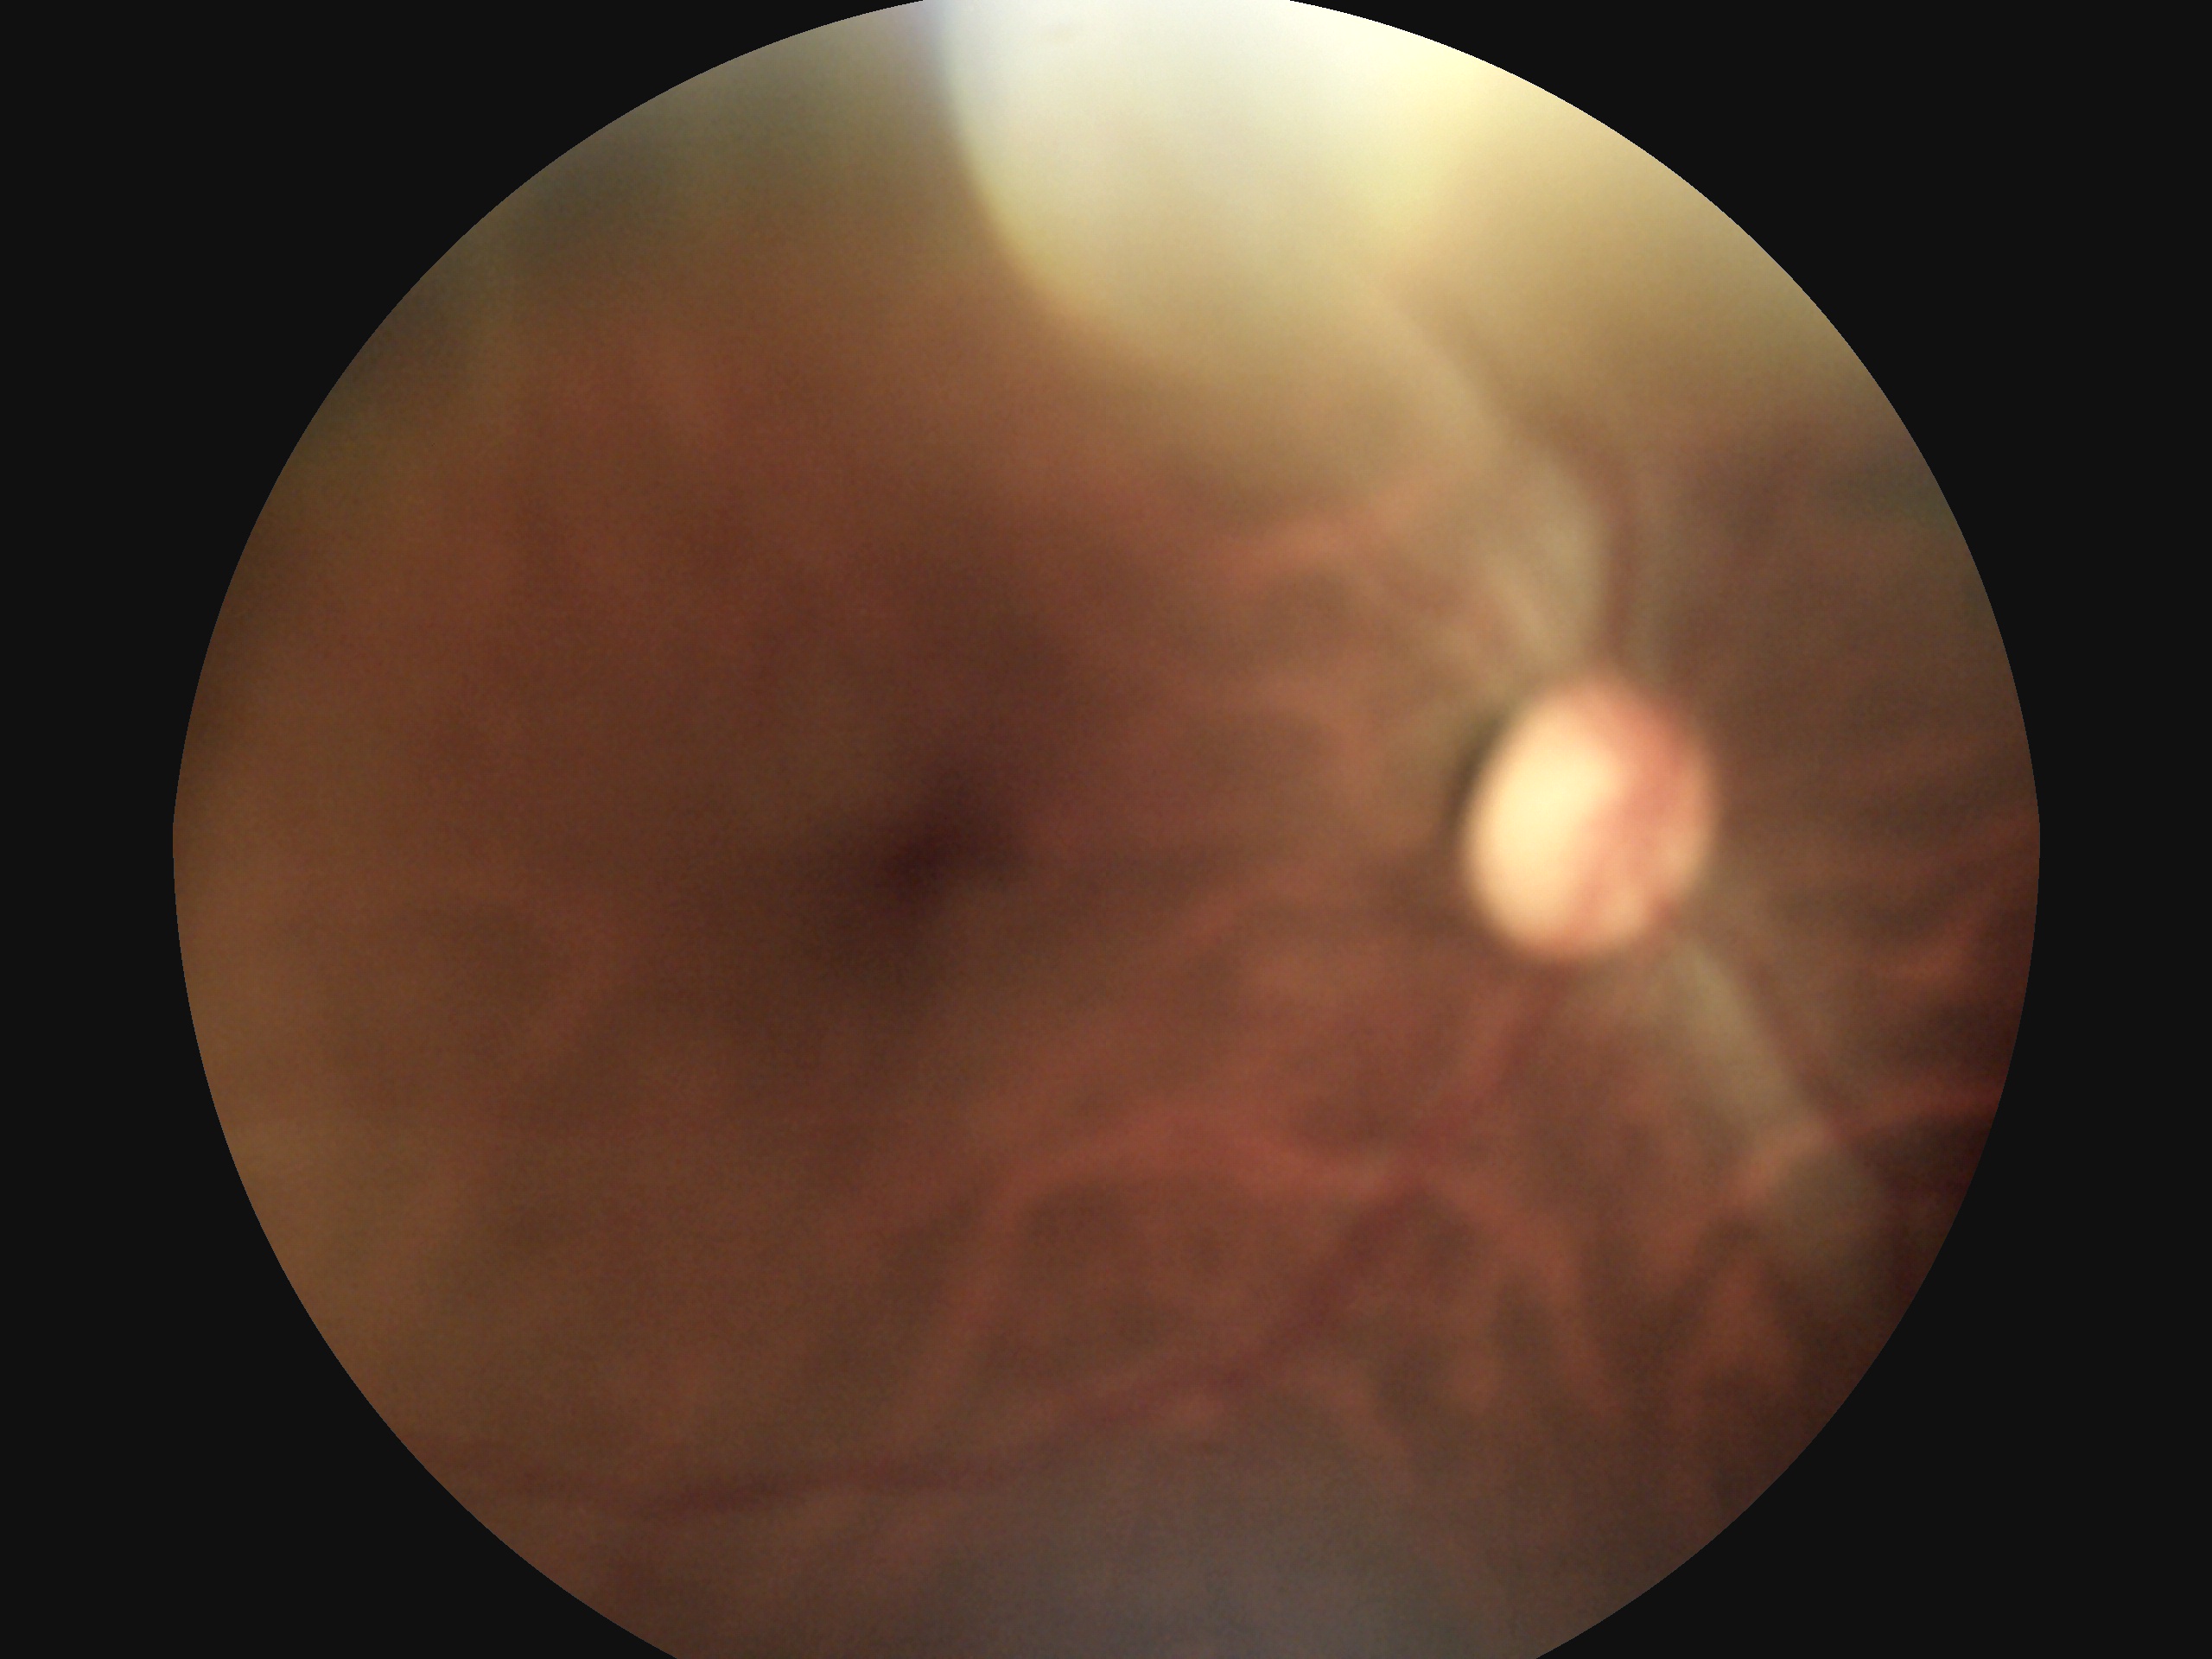
diabetic retinopathy (DR): 0/4.